Without pupil dilation; Davis DR grading; color fundus image; 848 x 848 pixels
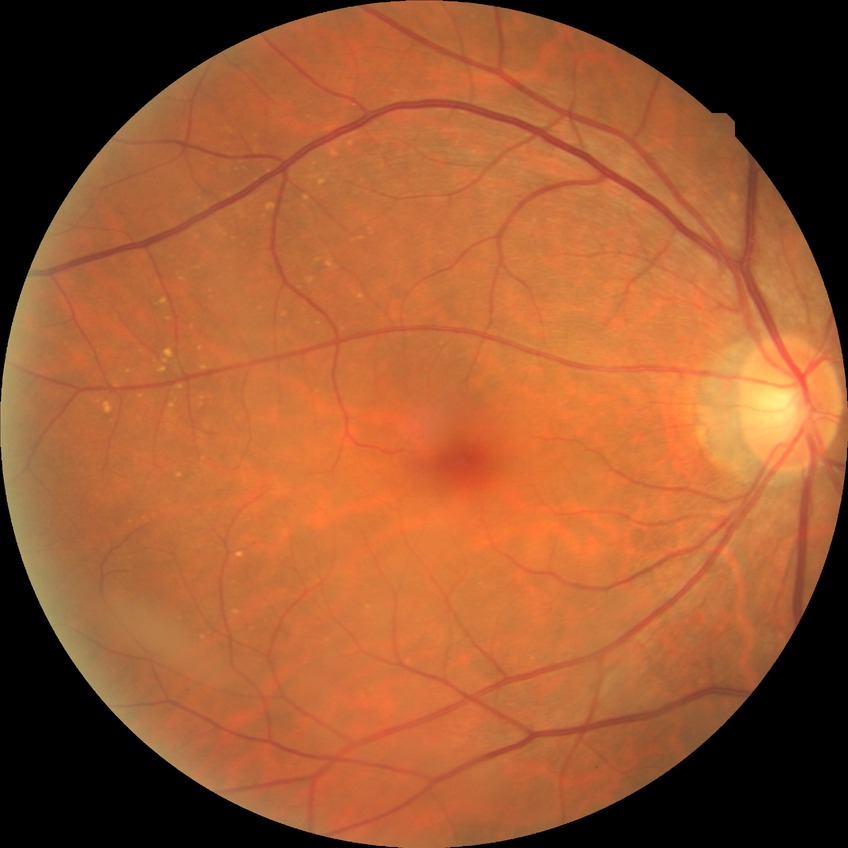
• Davis grade — NDR